50-degree field of view; field includes the optic disc and macula
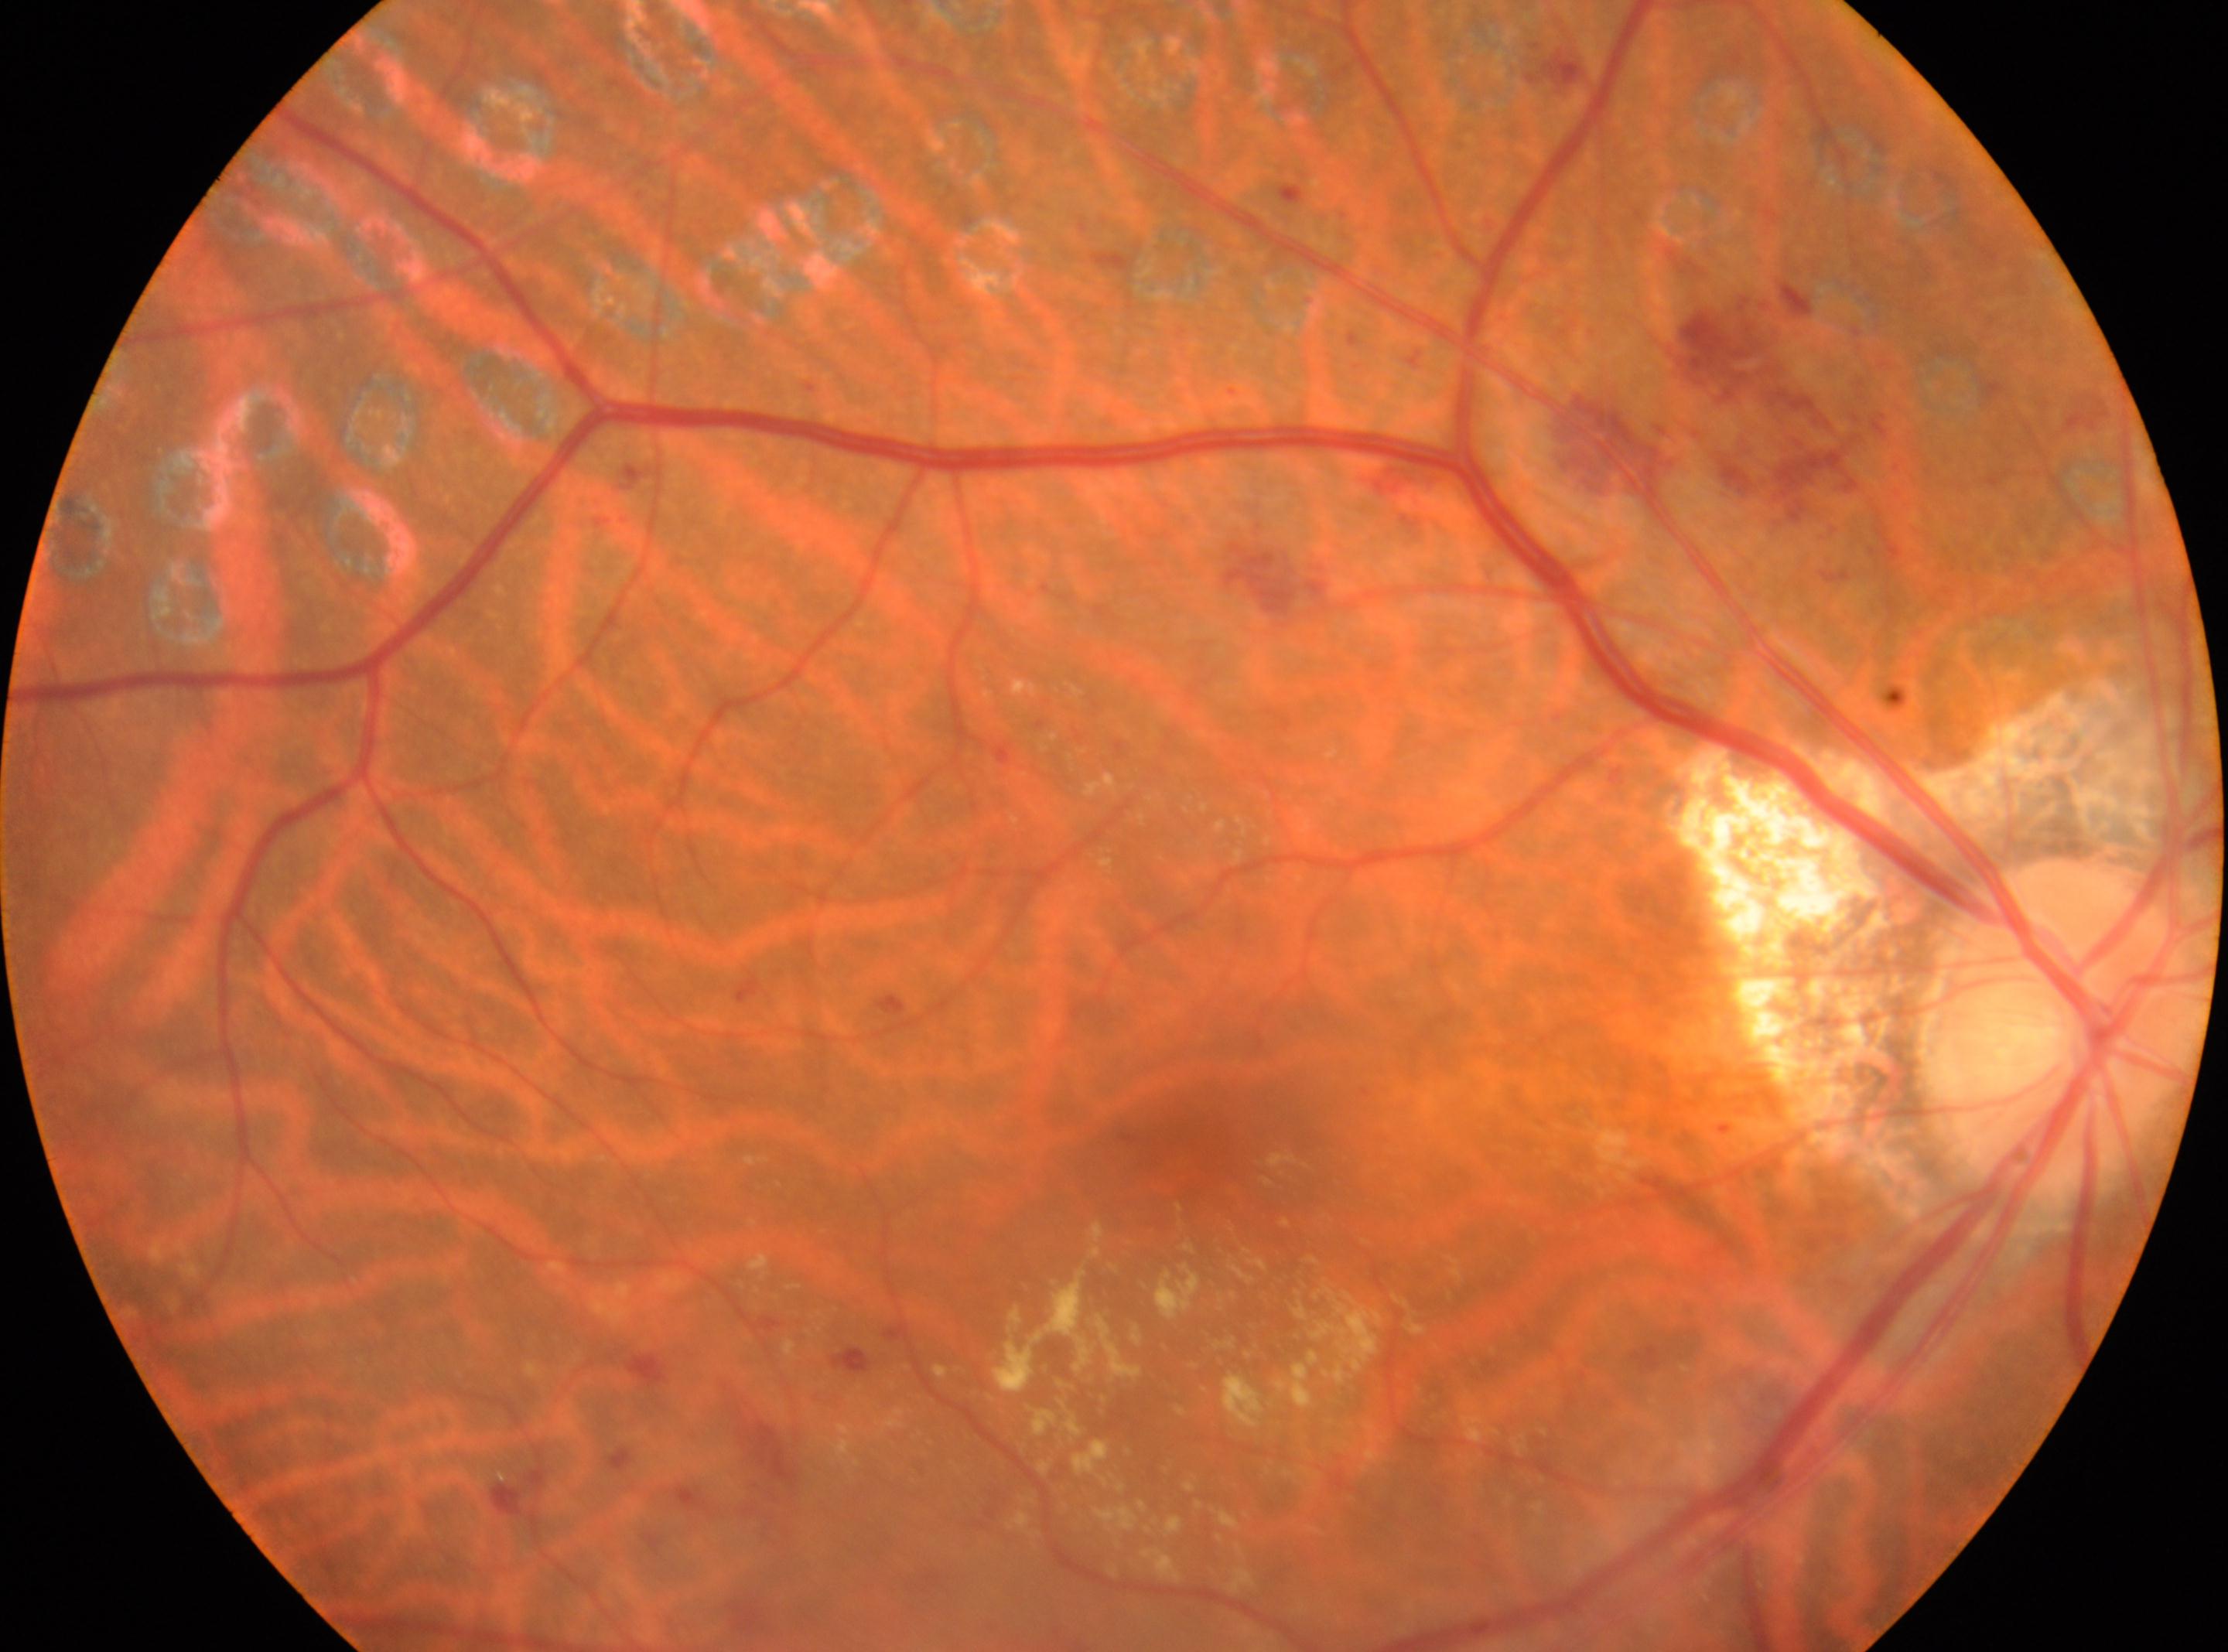 The ONH is at (2061,1026). Macula center located at (1194,1126). The image shows the OD. DR stage: laser-treated DR, underlying severity grade 2 (moderate NPDR).